Infant wide-field retinal image. Captured with the Natus RetCam Envision (130° field of view). 1440 by 1080 pixels: 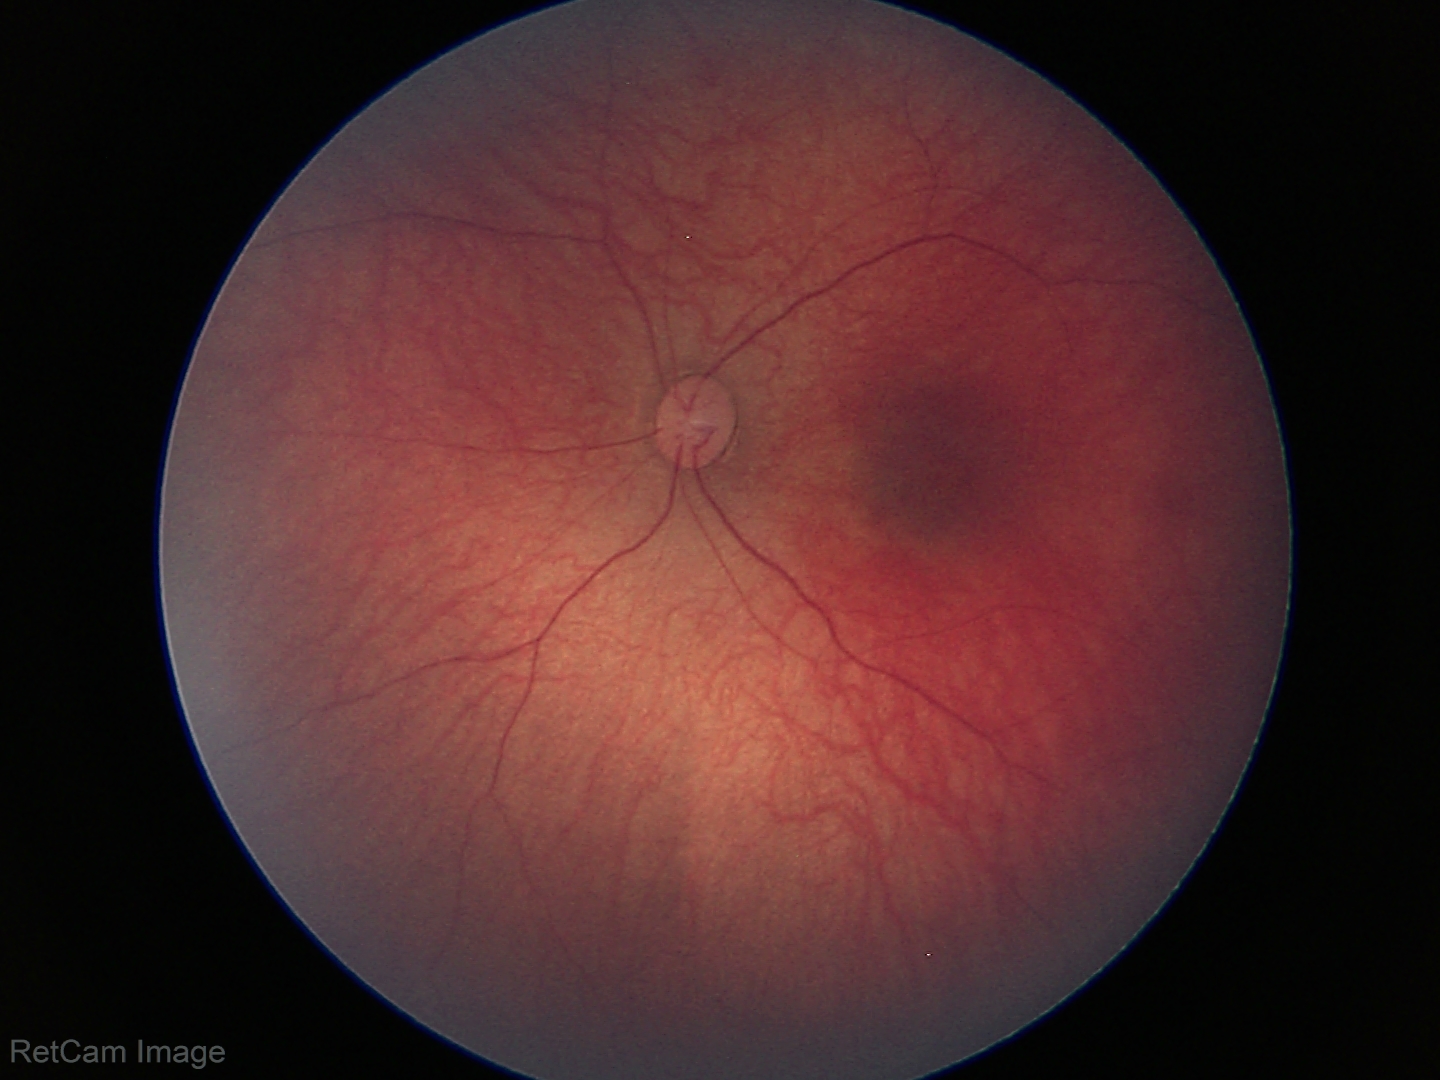 Finding: physiological.